Pediatric retinal photograph (wide-field). 640x480px.
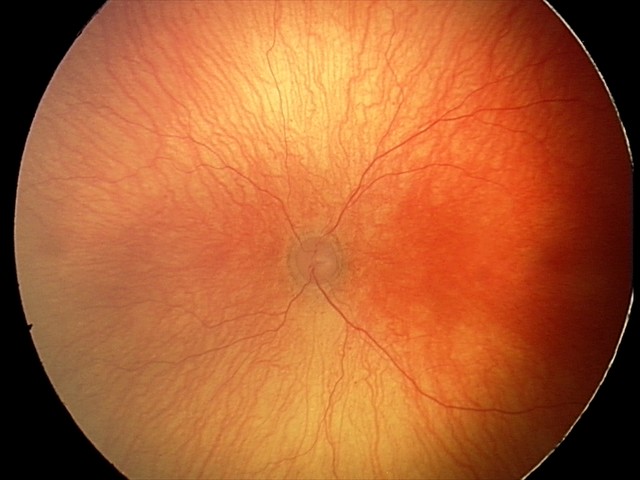
Examination diagnosed as aggressive retinopathy of prematurity.